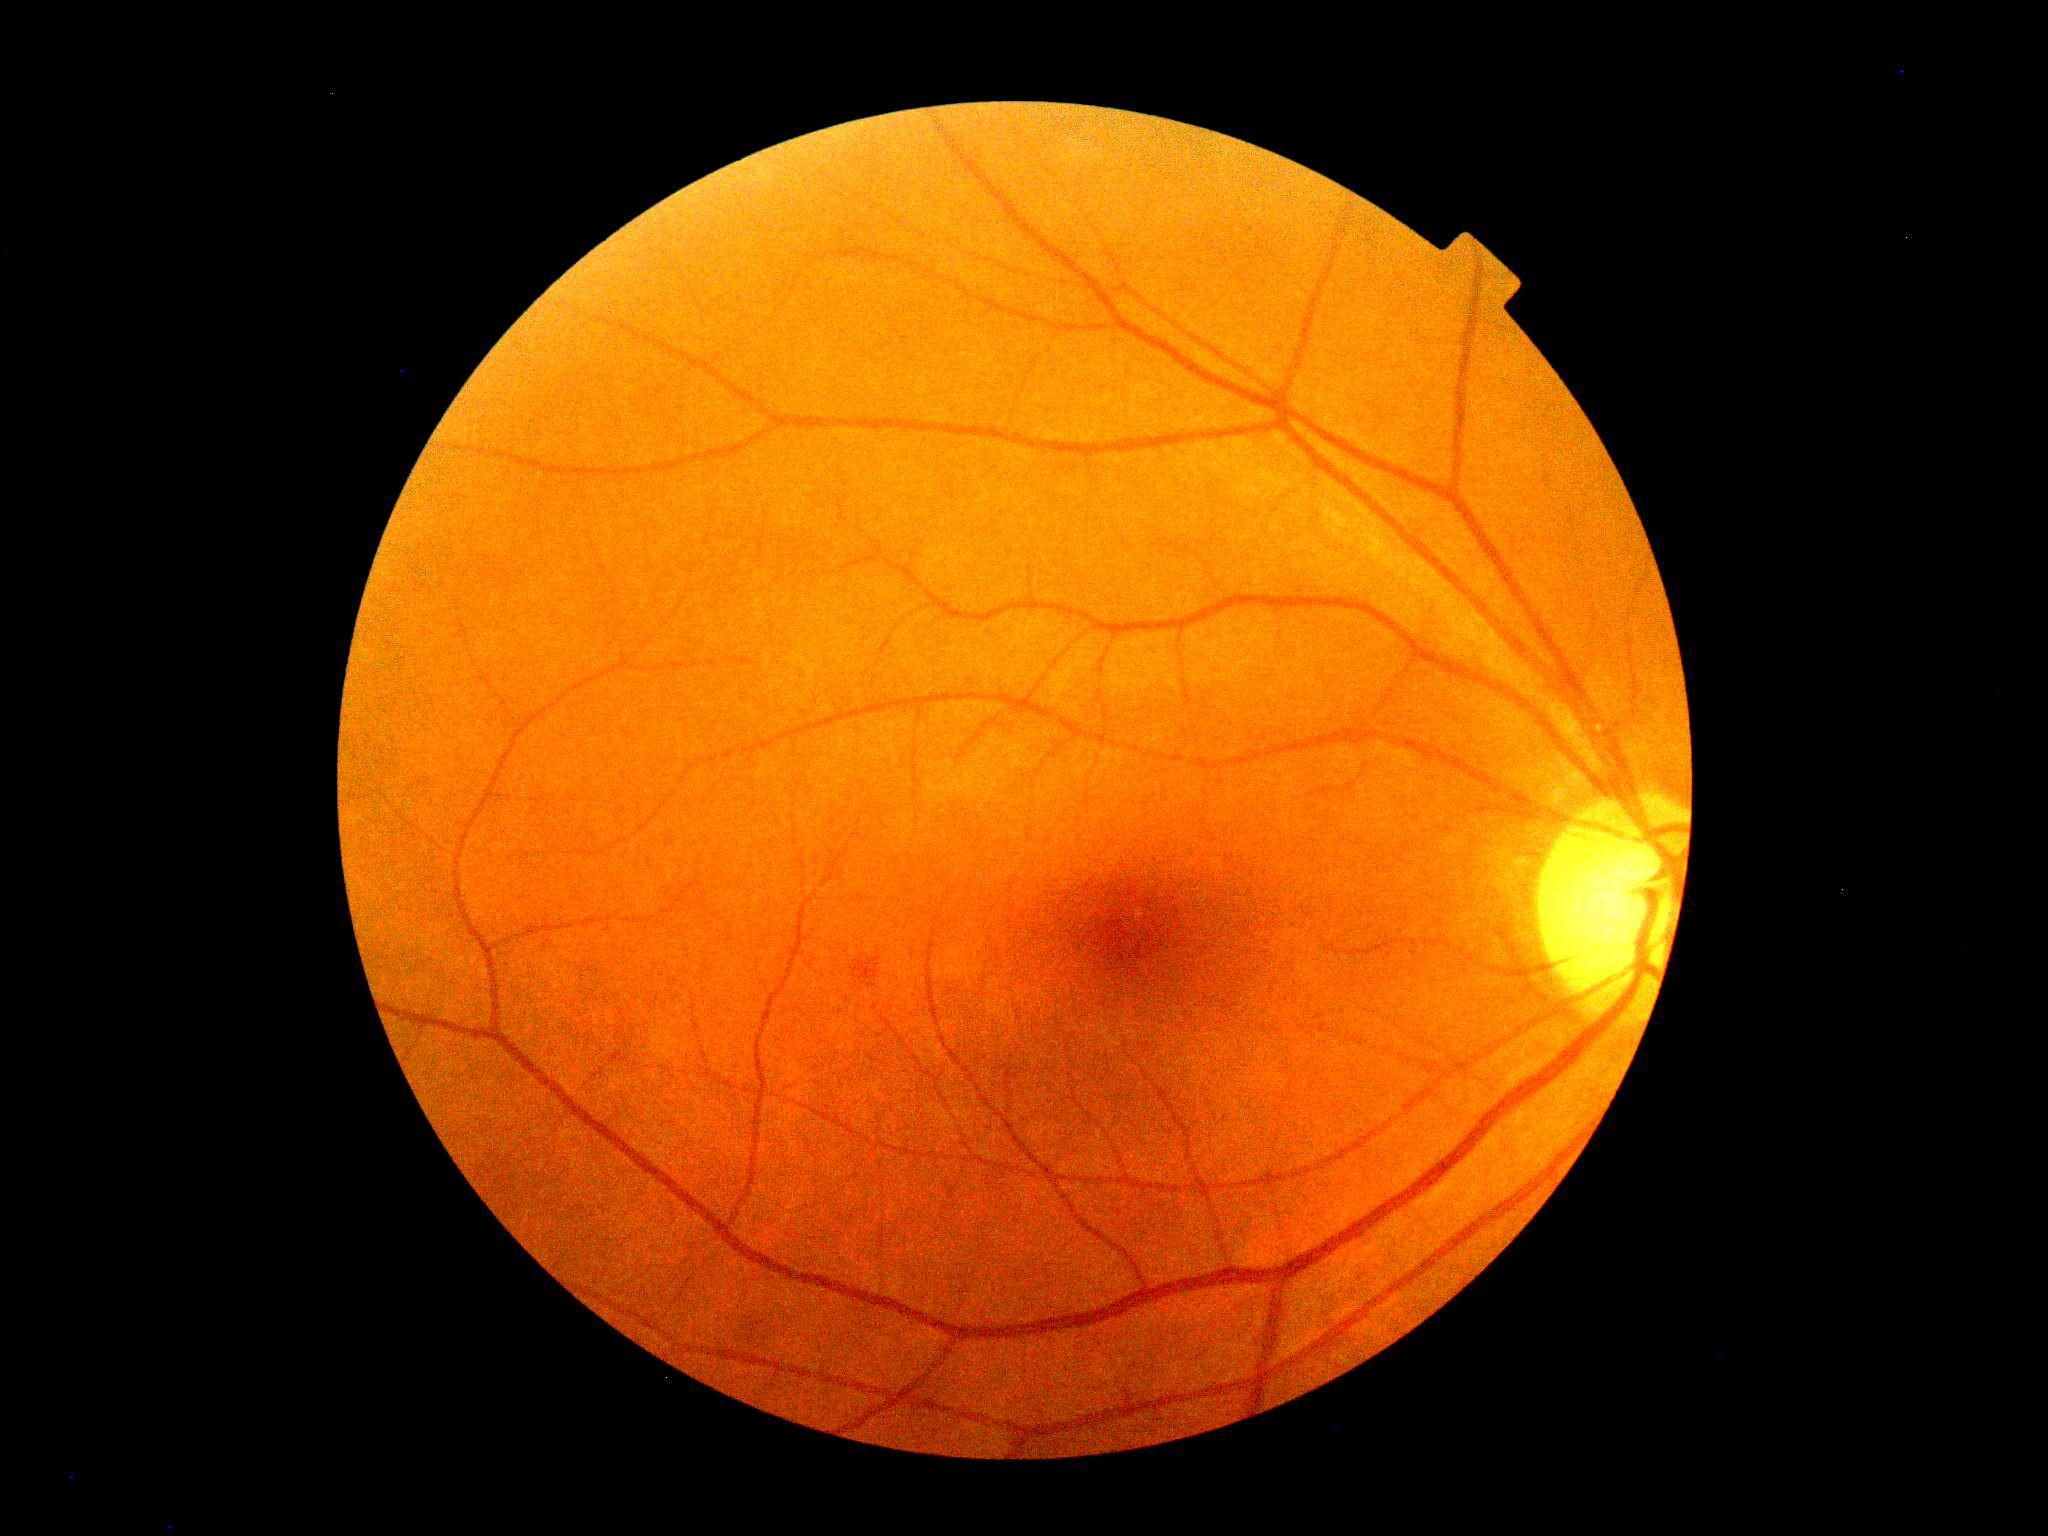
Retinopathy grade is 2.